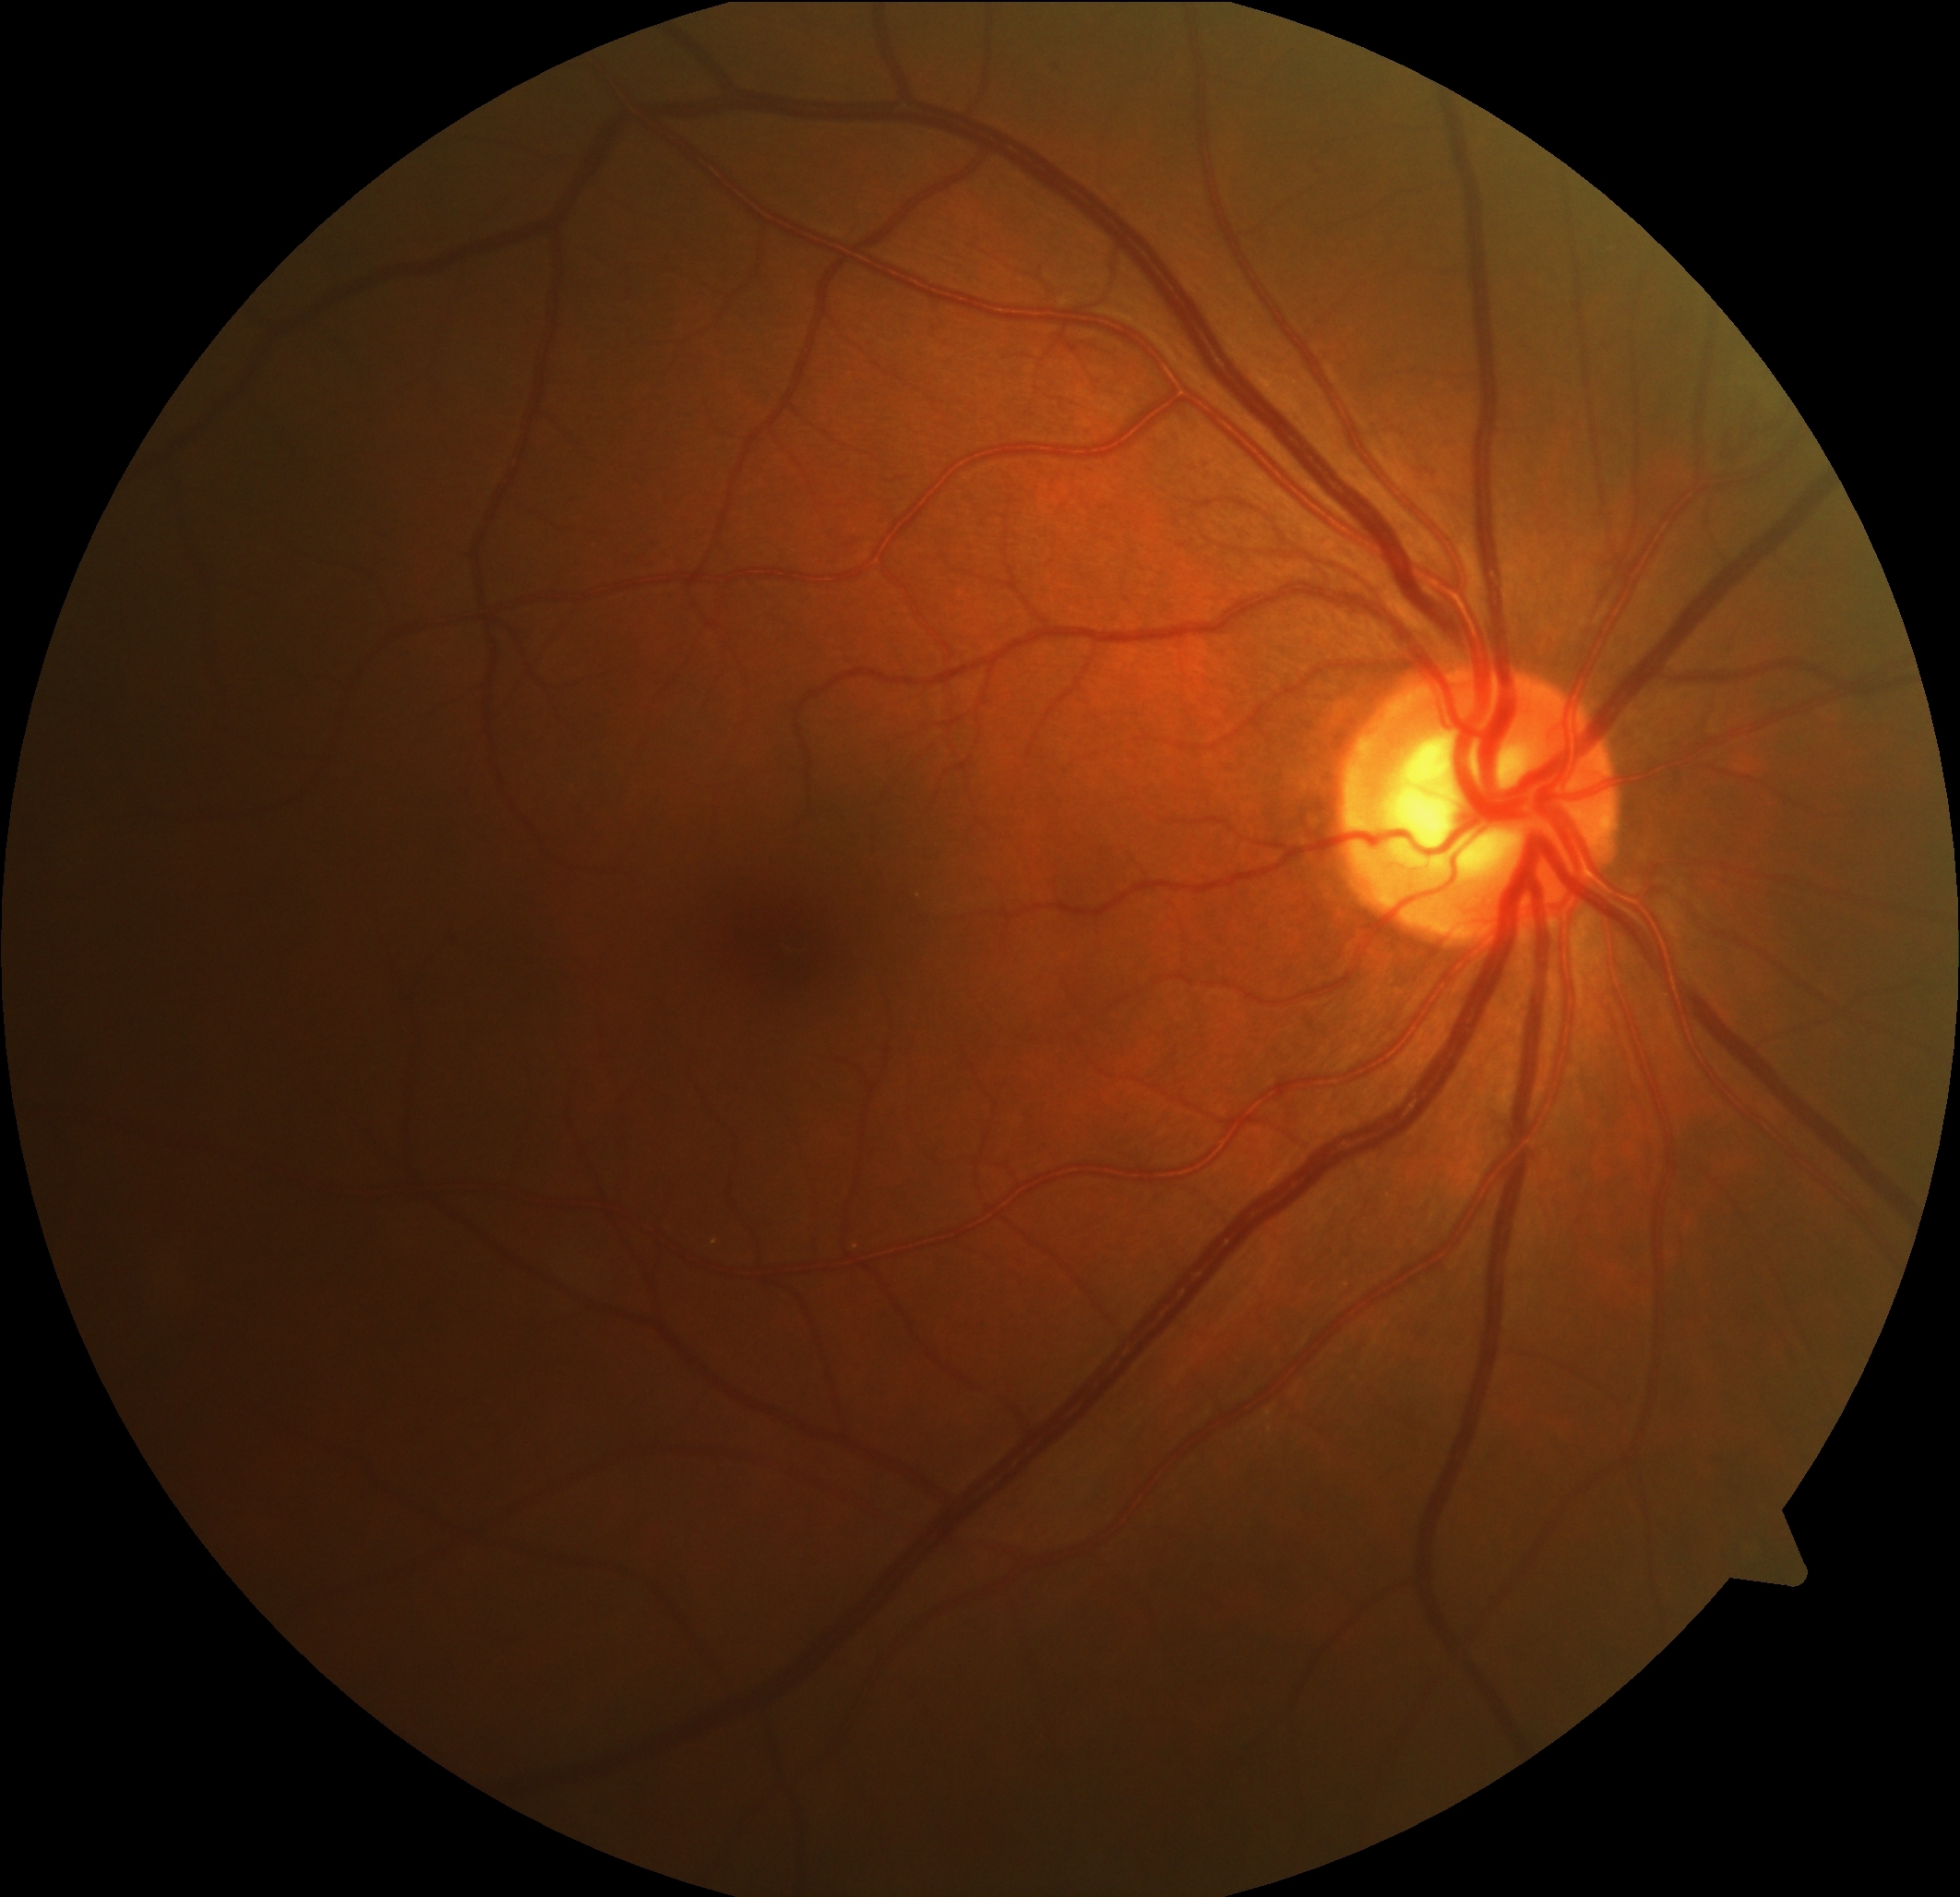
  dr_grade: grade 0 (no apparent retinopathy)